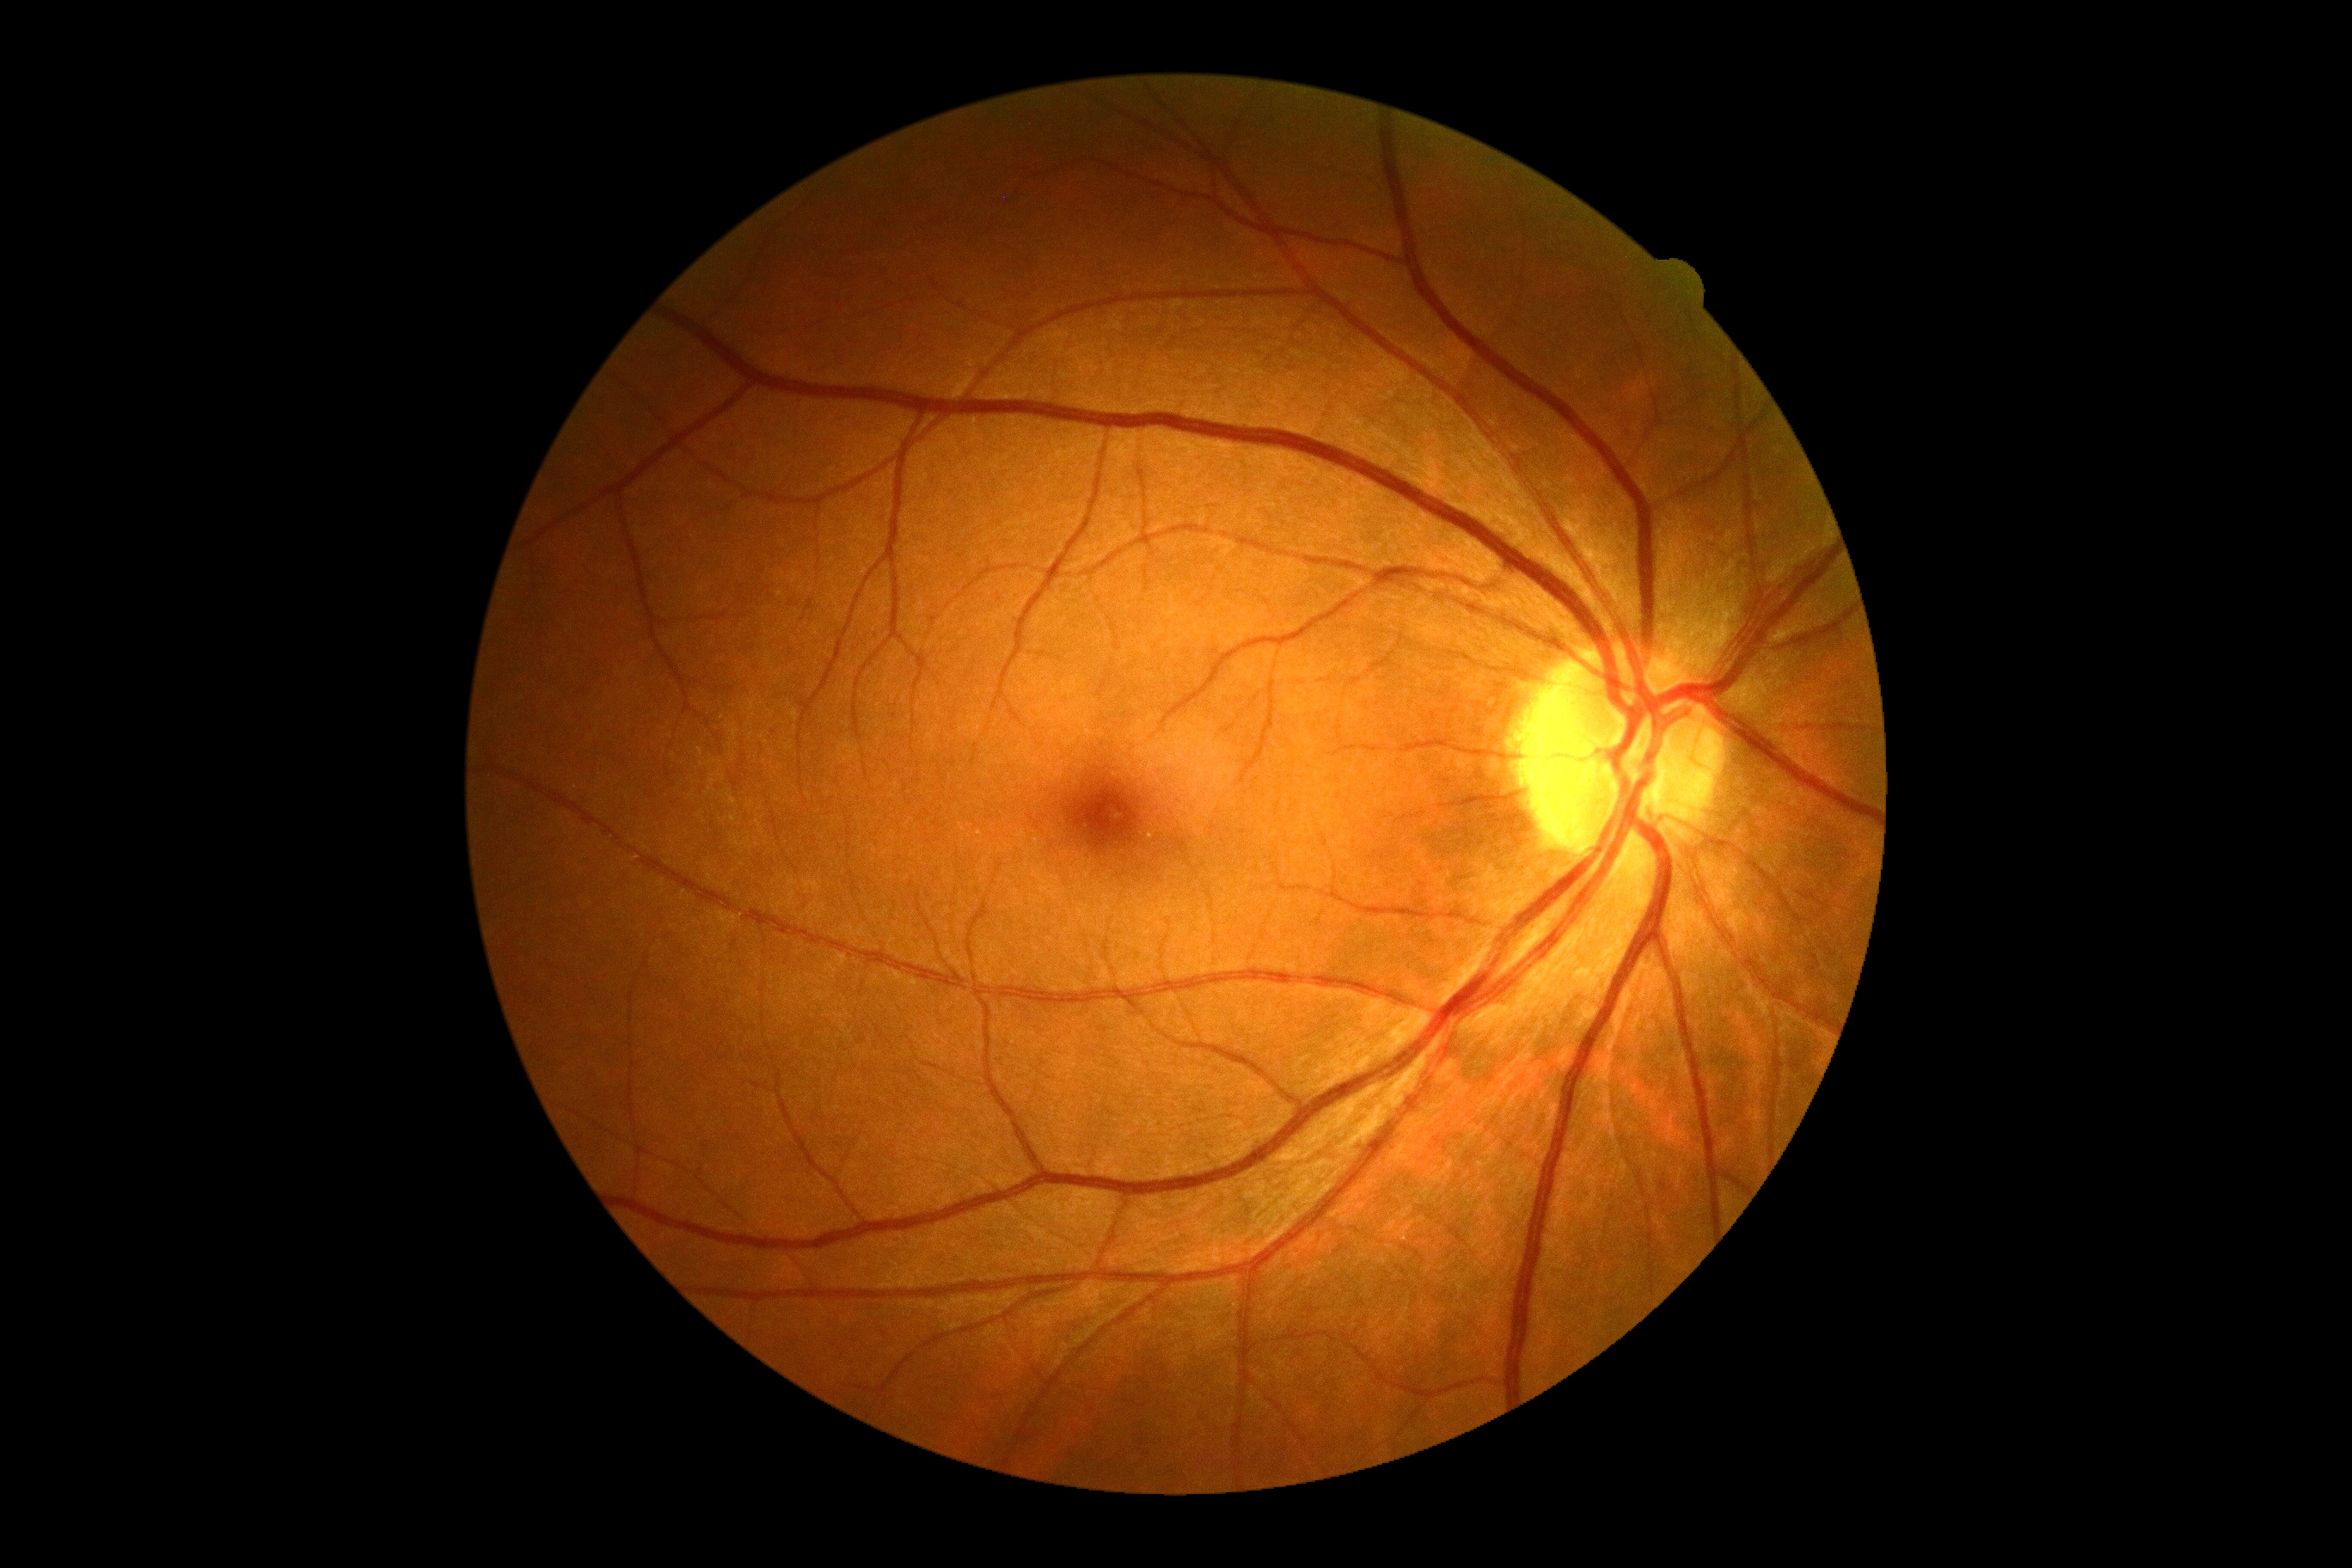
diabetic retinopathy grade = 0, DR impression = no signs of DR.